FOV: 45 degrees; 2352 by 1568 pixels:
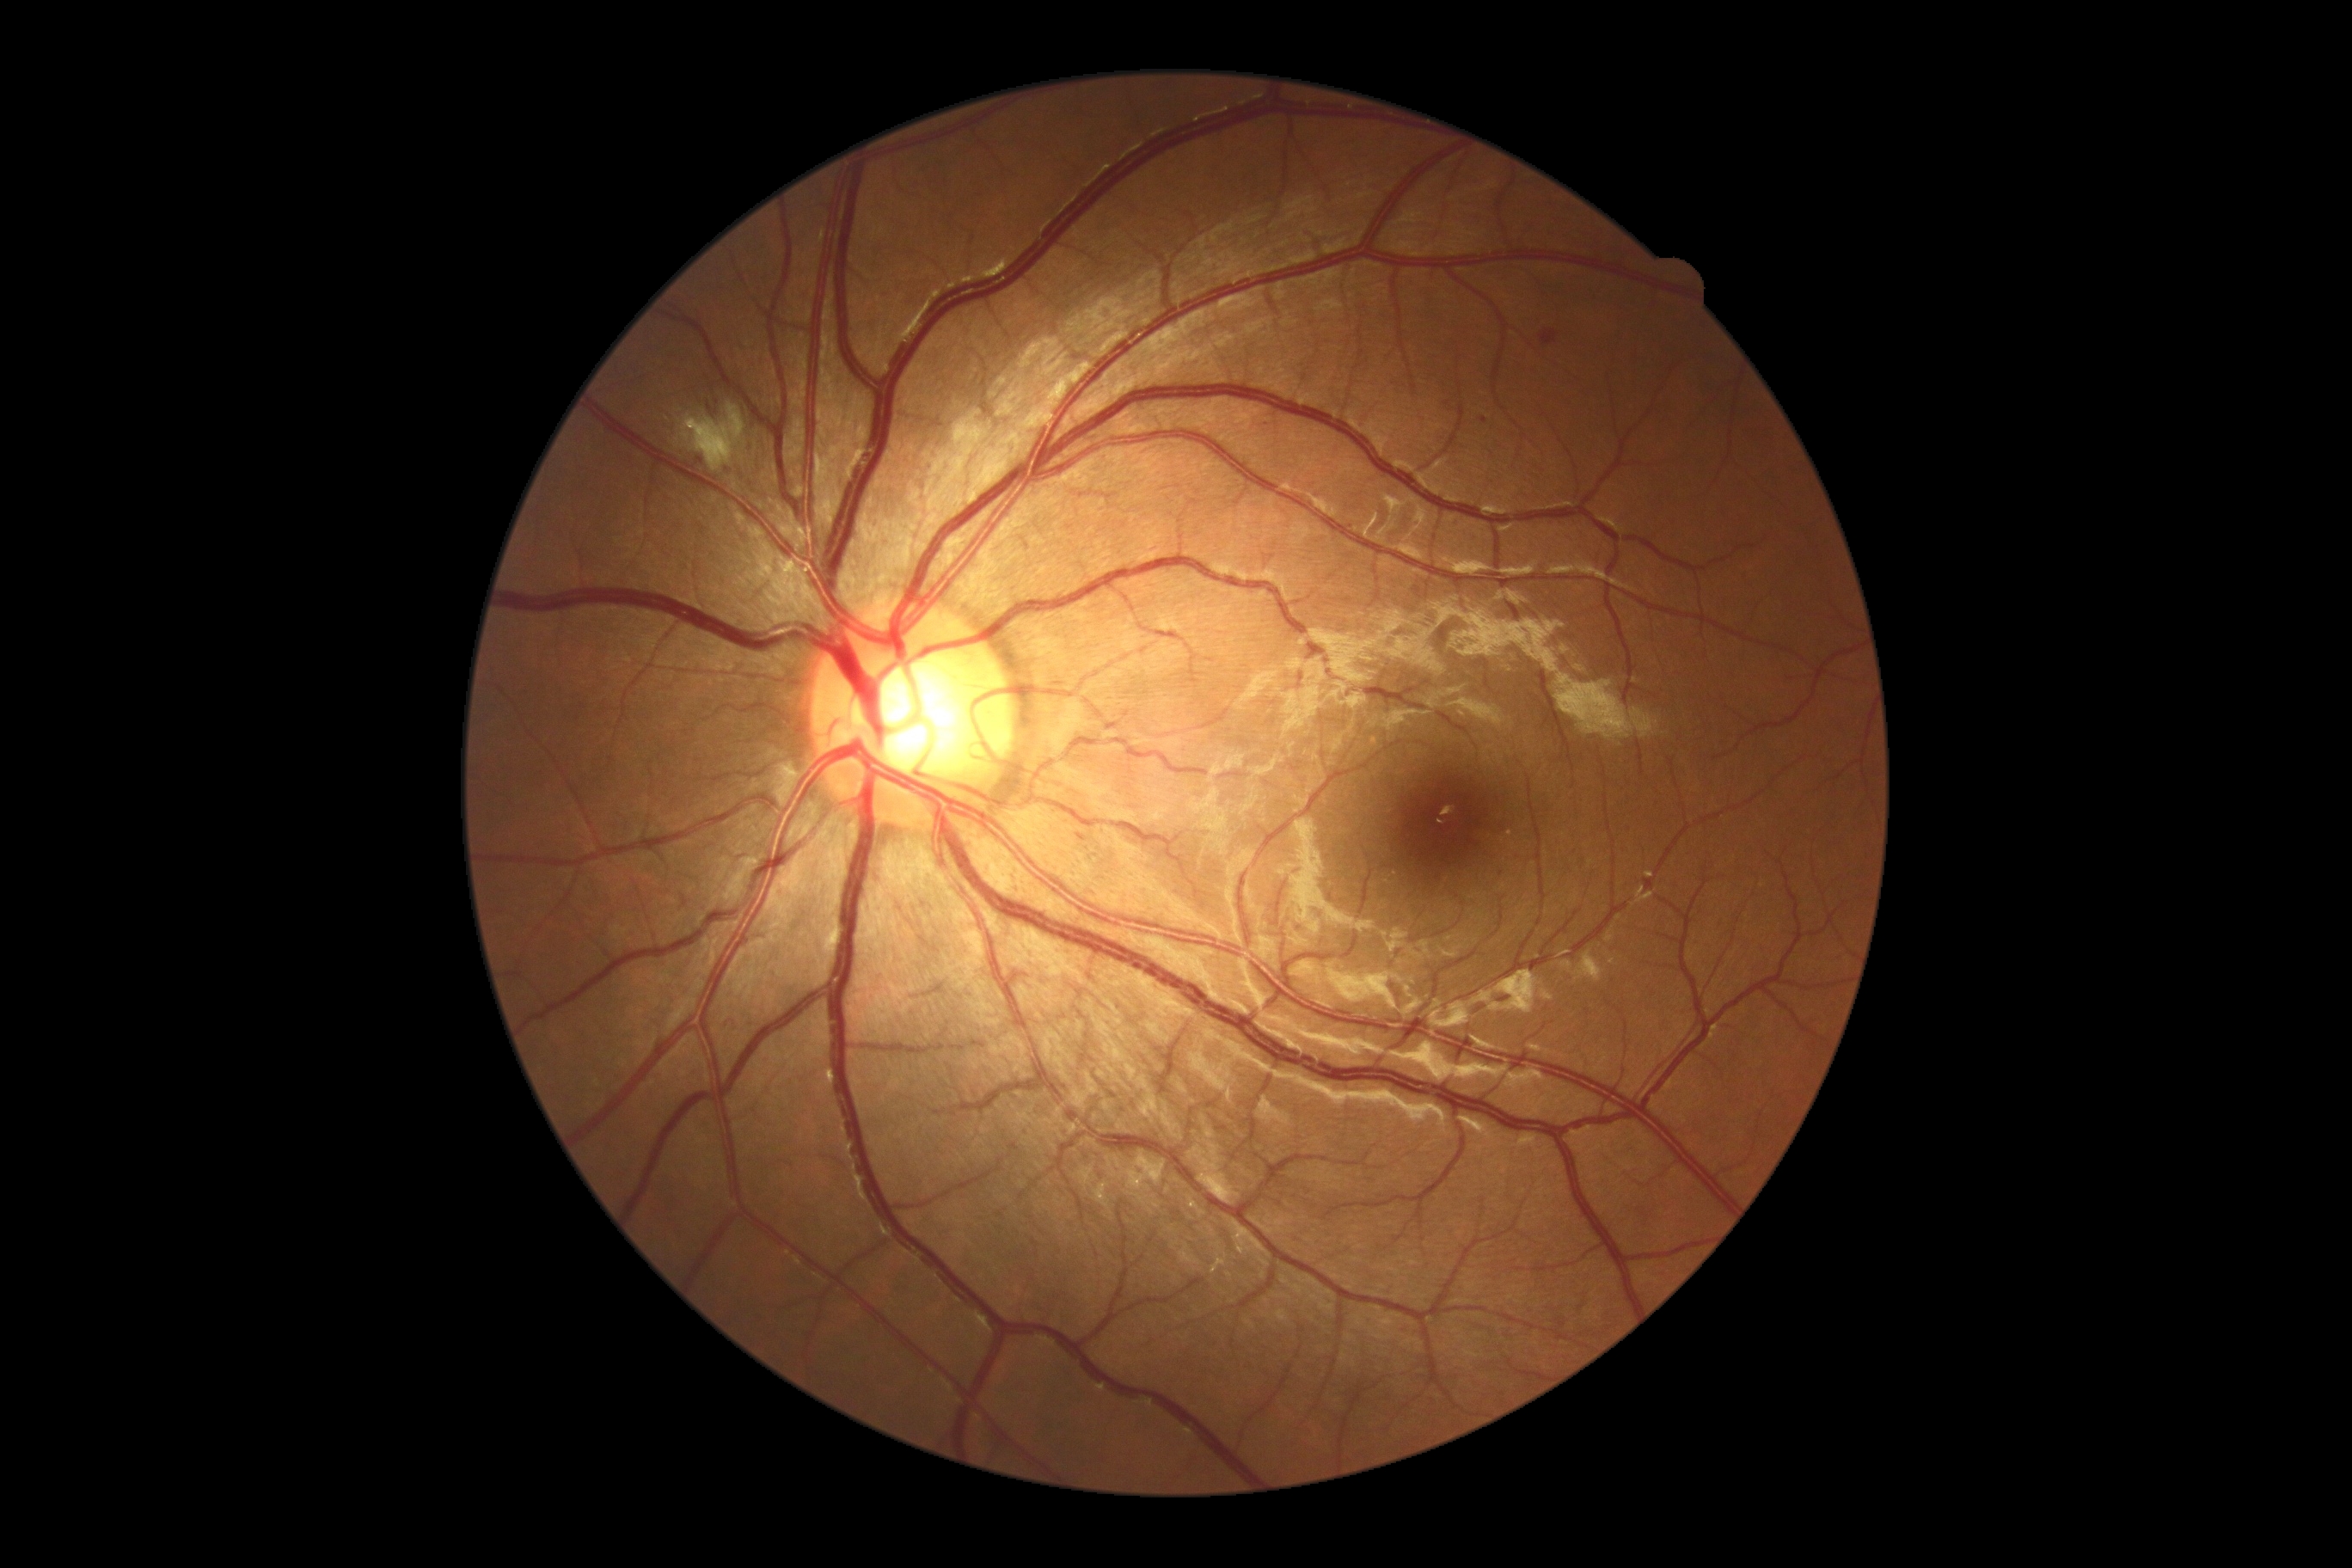

Diabetic retinopathy severity is moderate NPDR (grade 2).